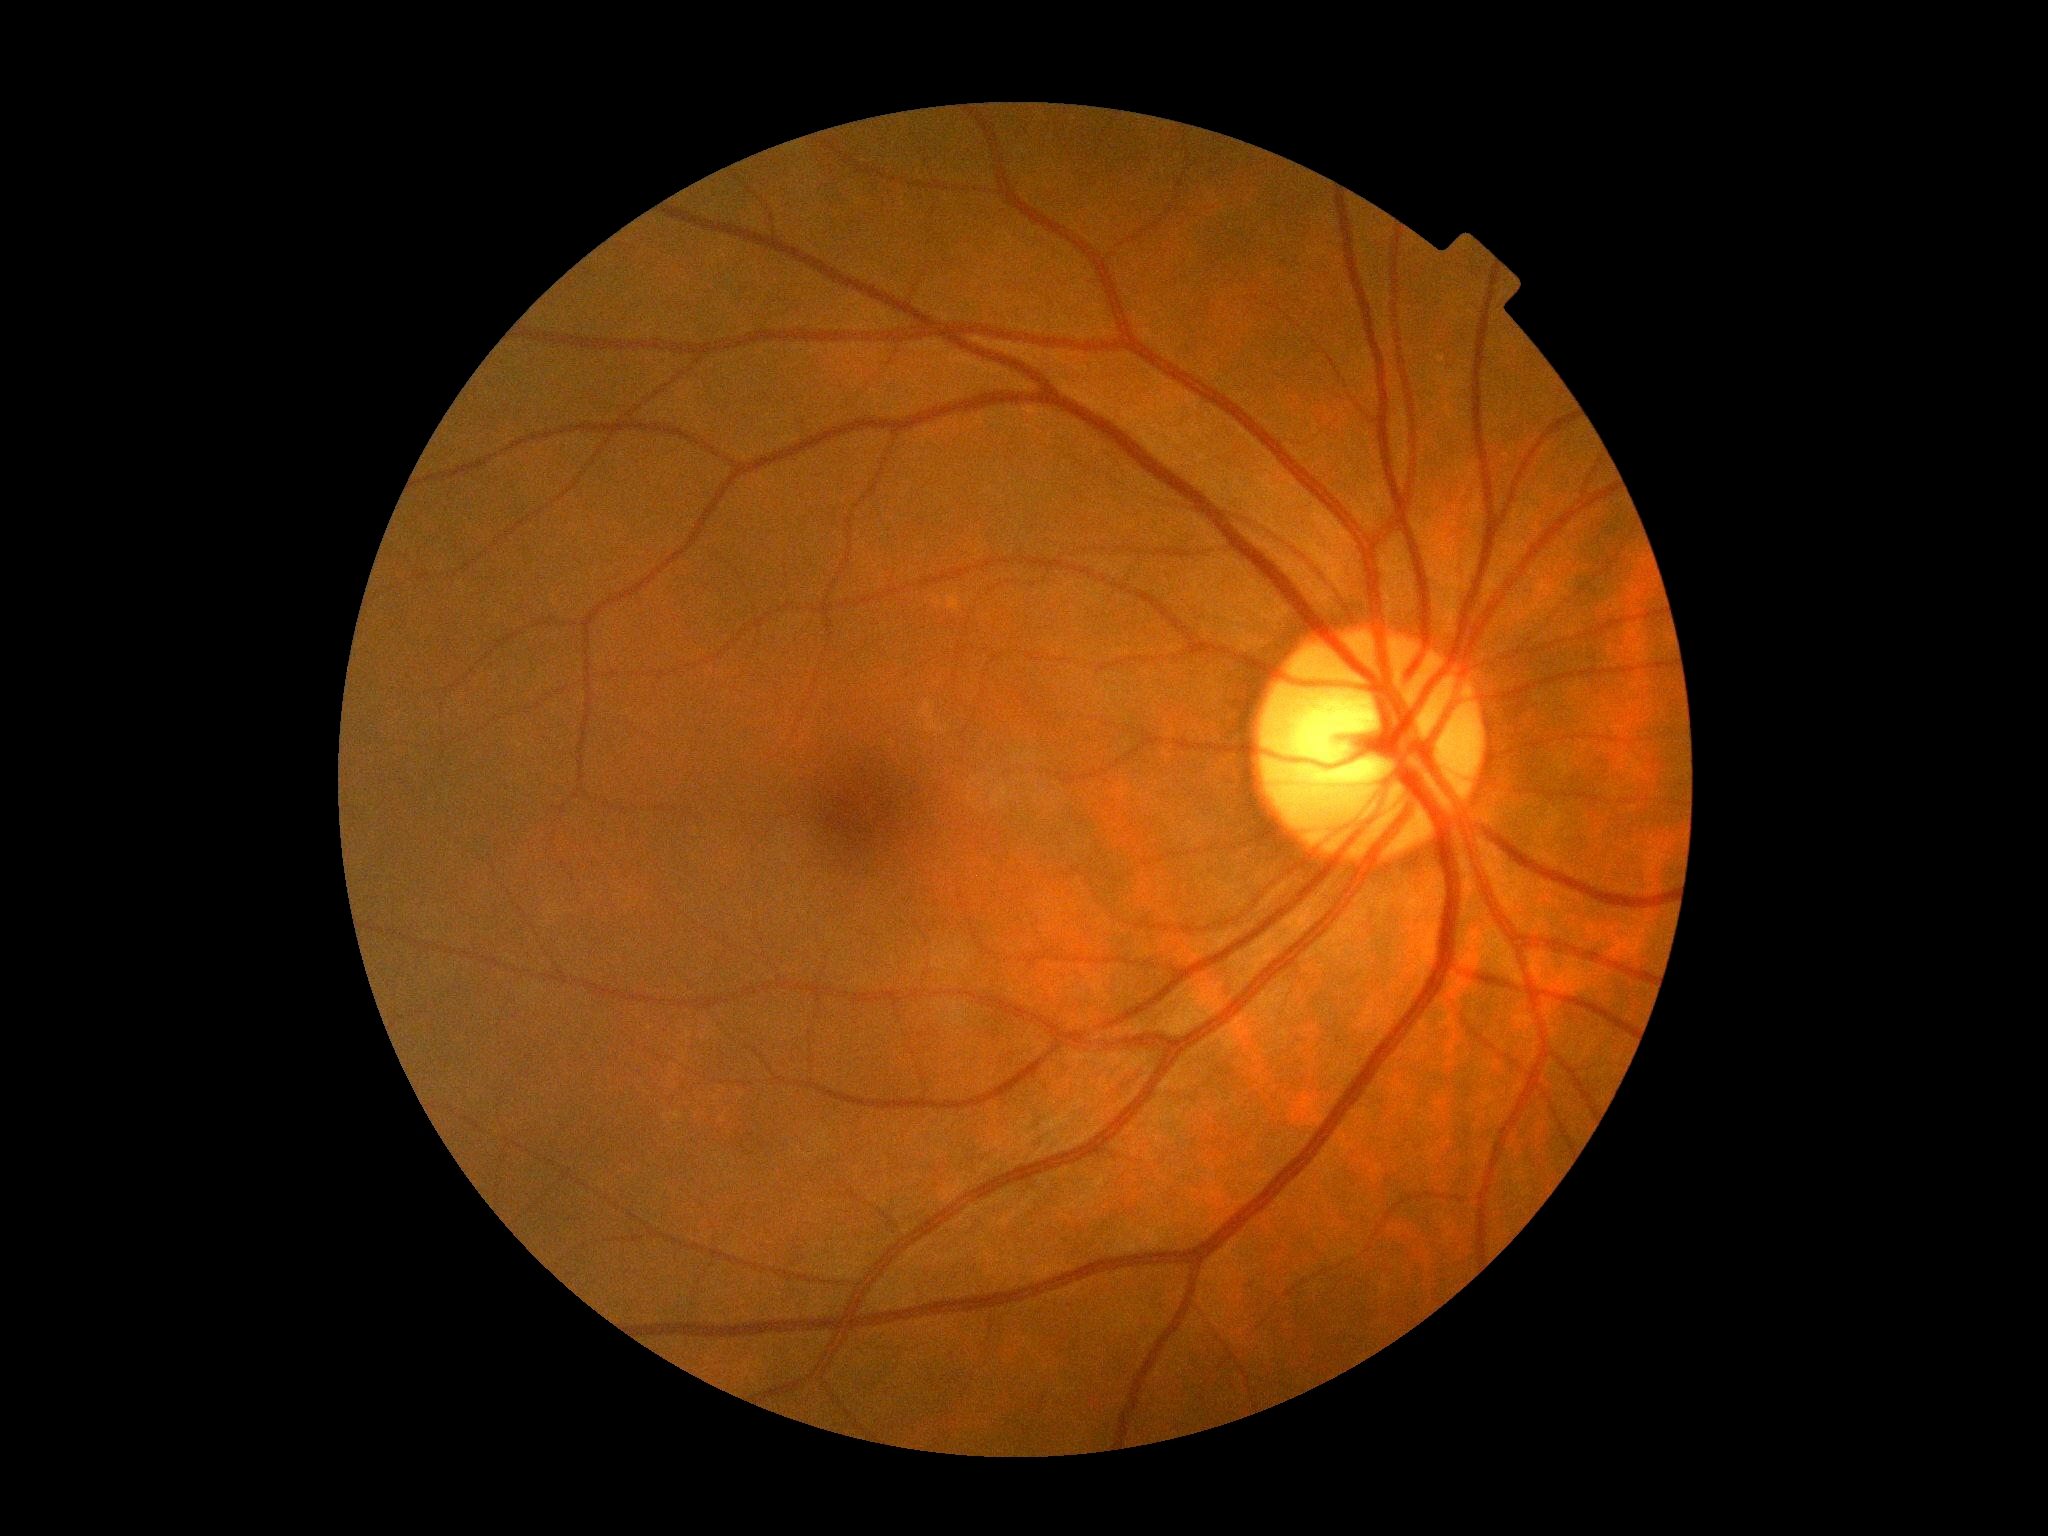
DR=grade 0 (no apparent retinopathy), DR impression=no signs of DR.